Posterior pole color fundus photograph.
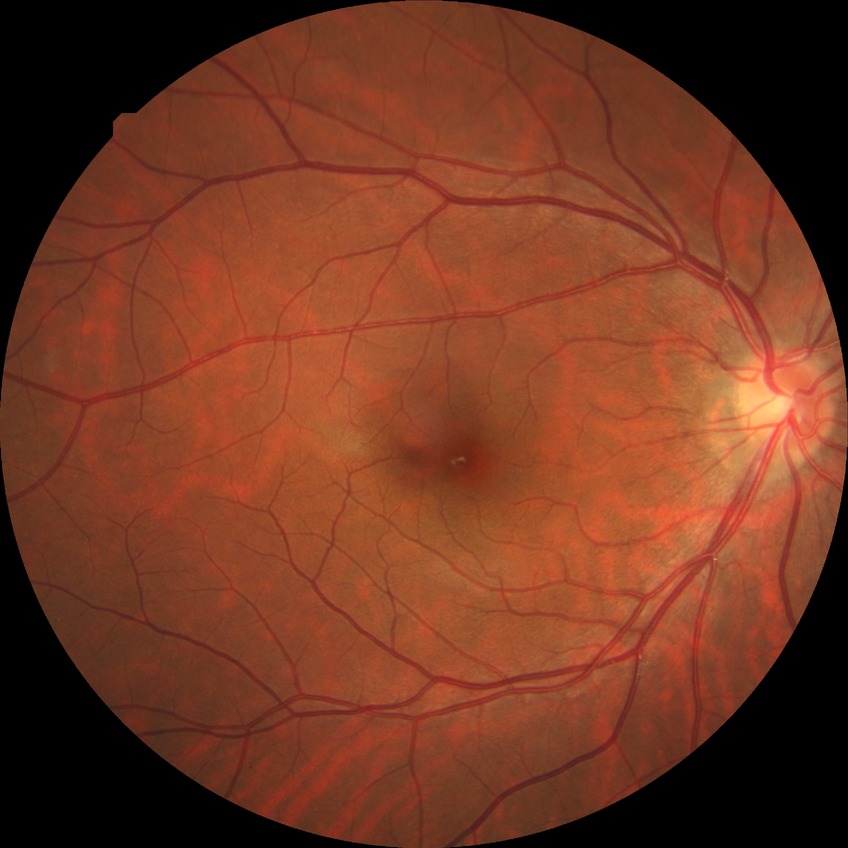
Diabetic retinopathy (DR): no diabetic retinopathy (NDR).